Fundus photo; 2352 x 1568 pixels; 45° field of view — 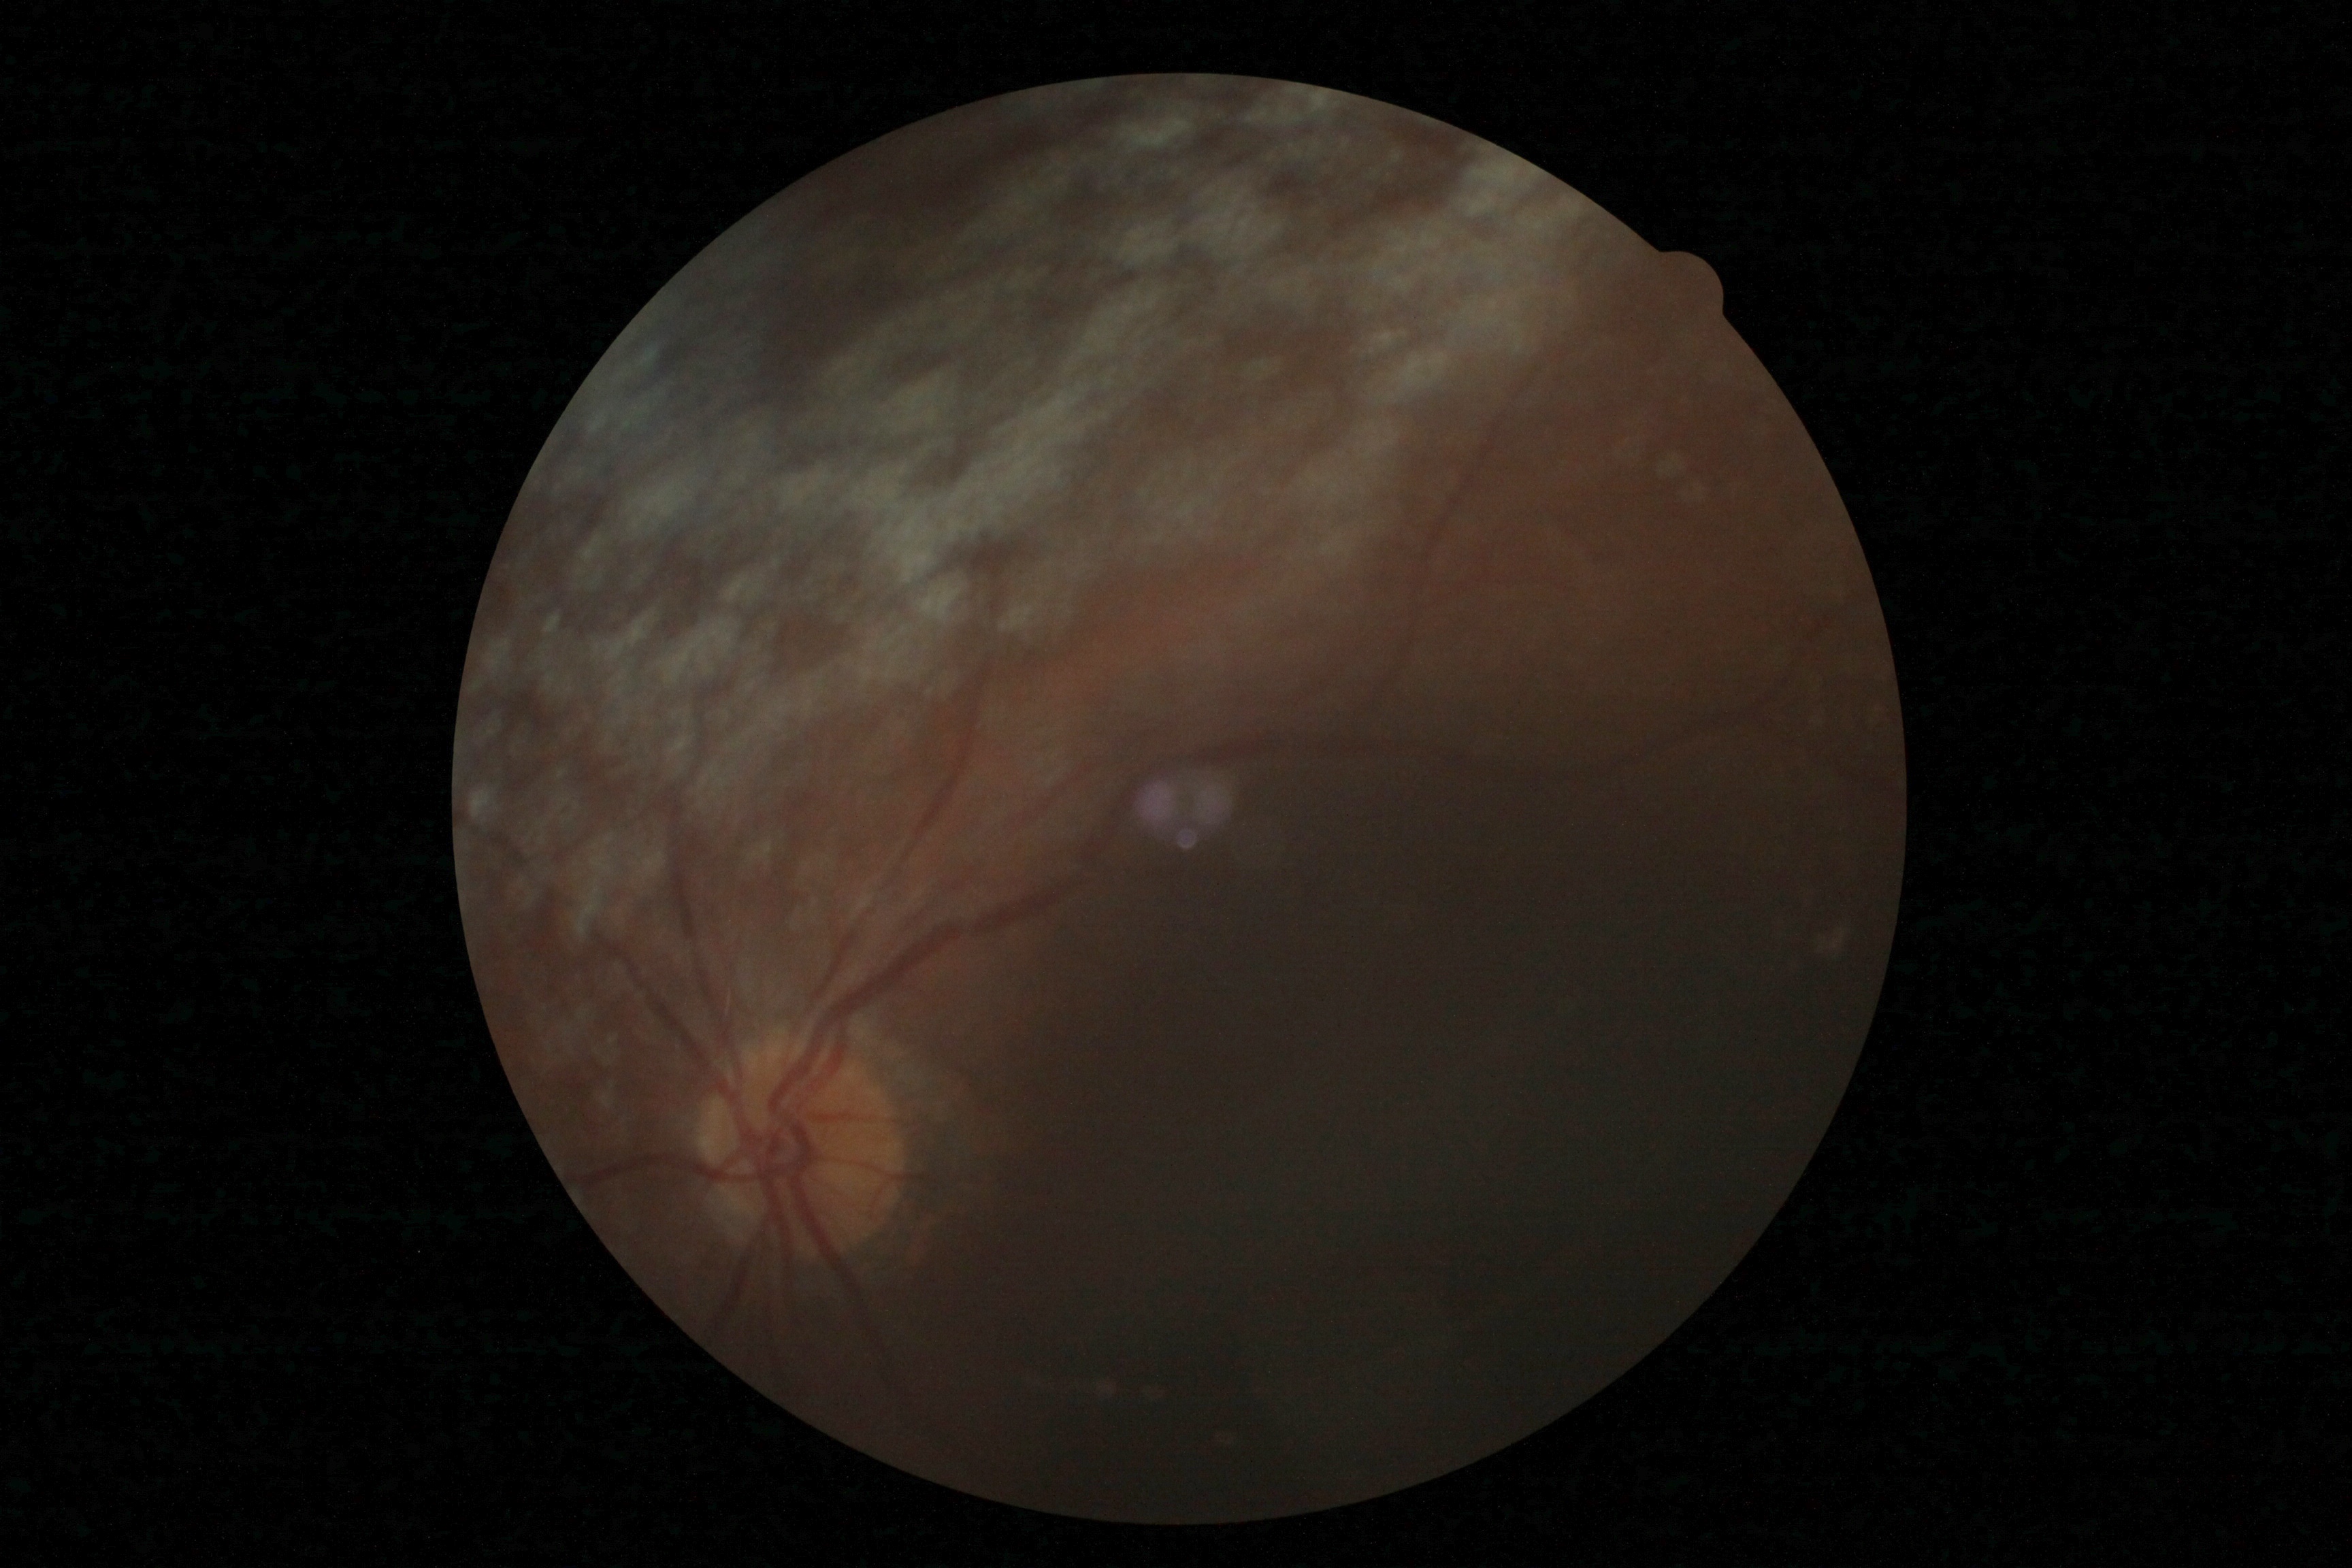

Quality too poor to assess for DR. Diabetic retinopathy grade is ungradable due to poor image quality.